45° field of view — 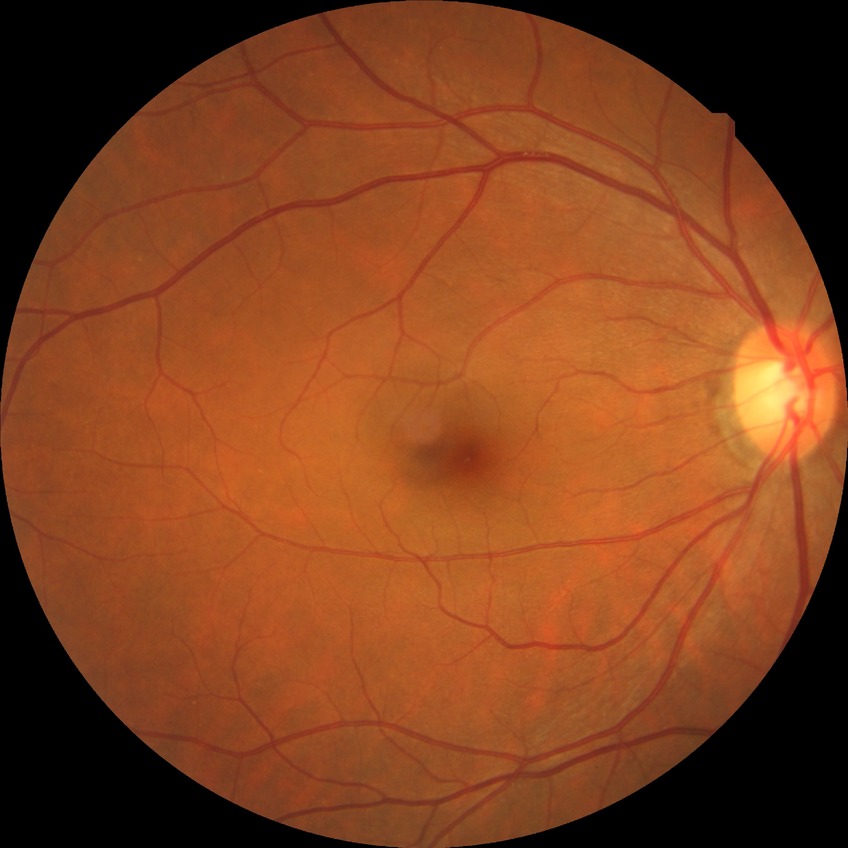 Diabetic retinopathy severity: no diabetic retinopathy.